1440x1080px · RetCam wide-field infant fundus image:
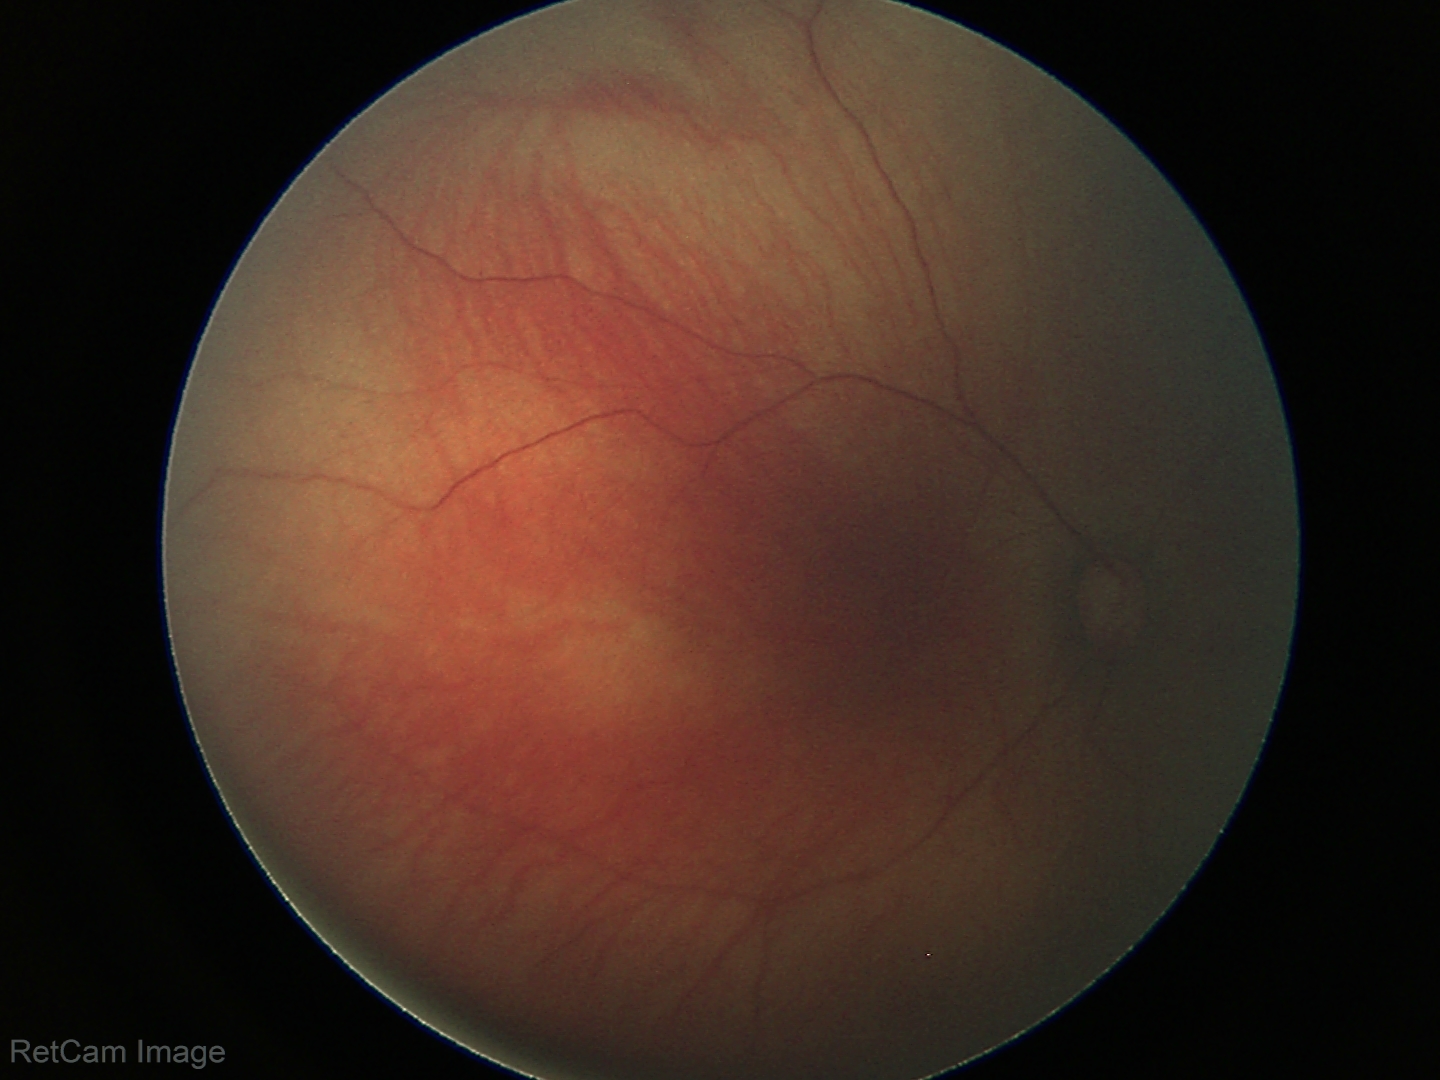
Physiological retinal appearance for postconceptual age.